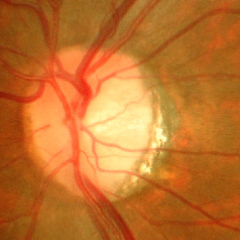 Optic disc photograph demonstrating severe glaucomatous damage.